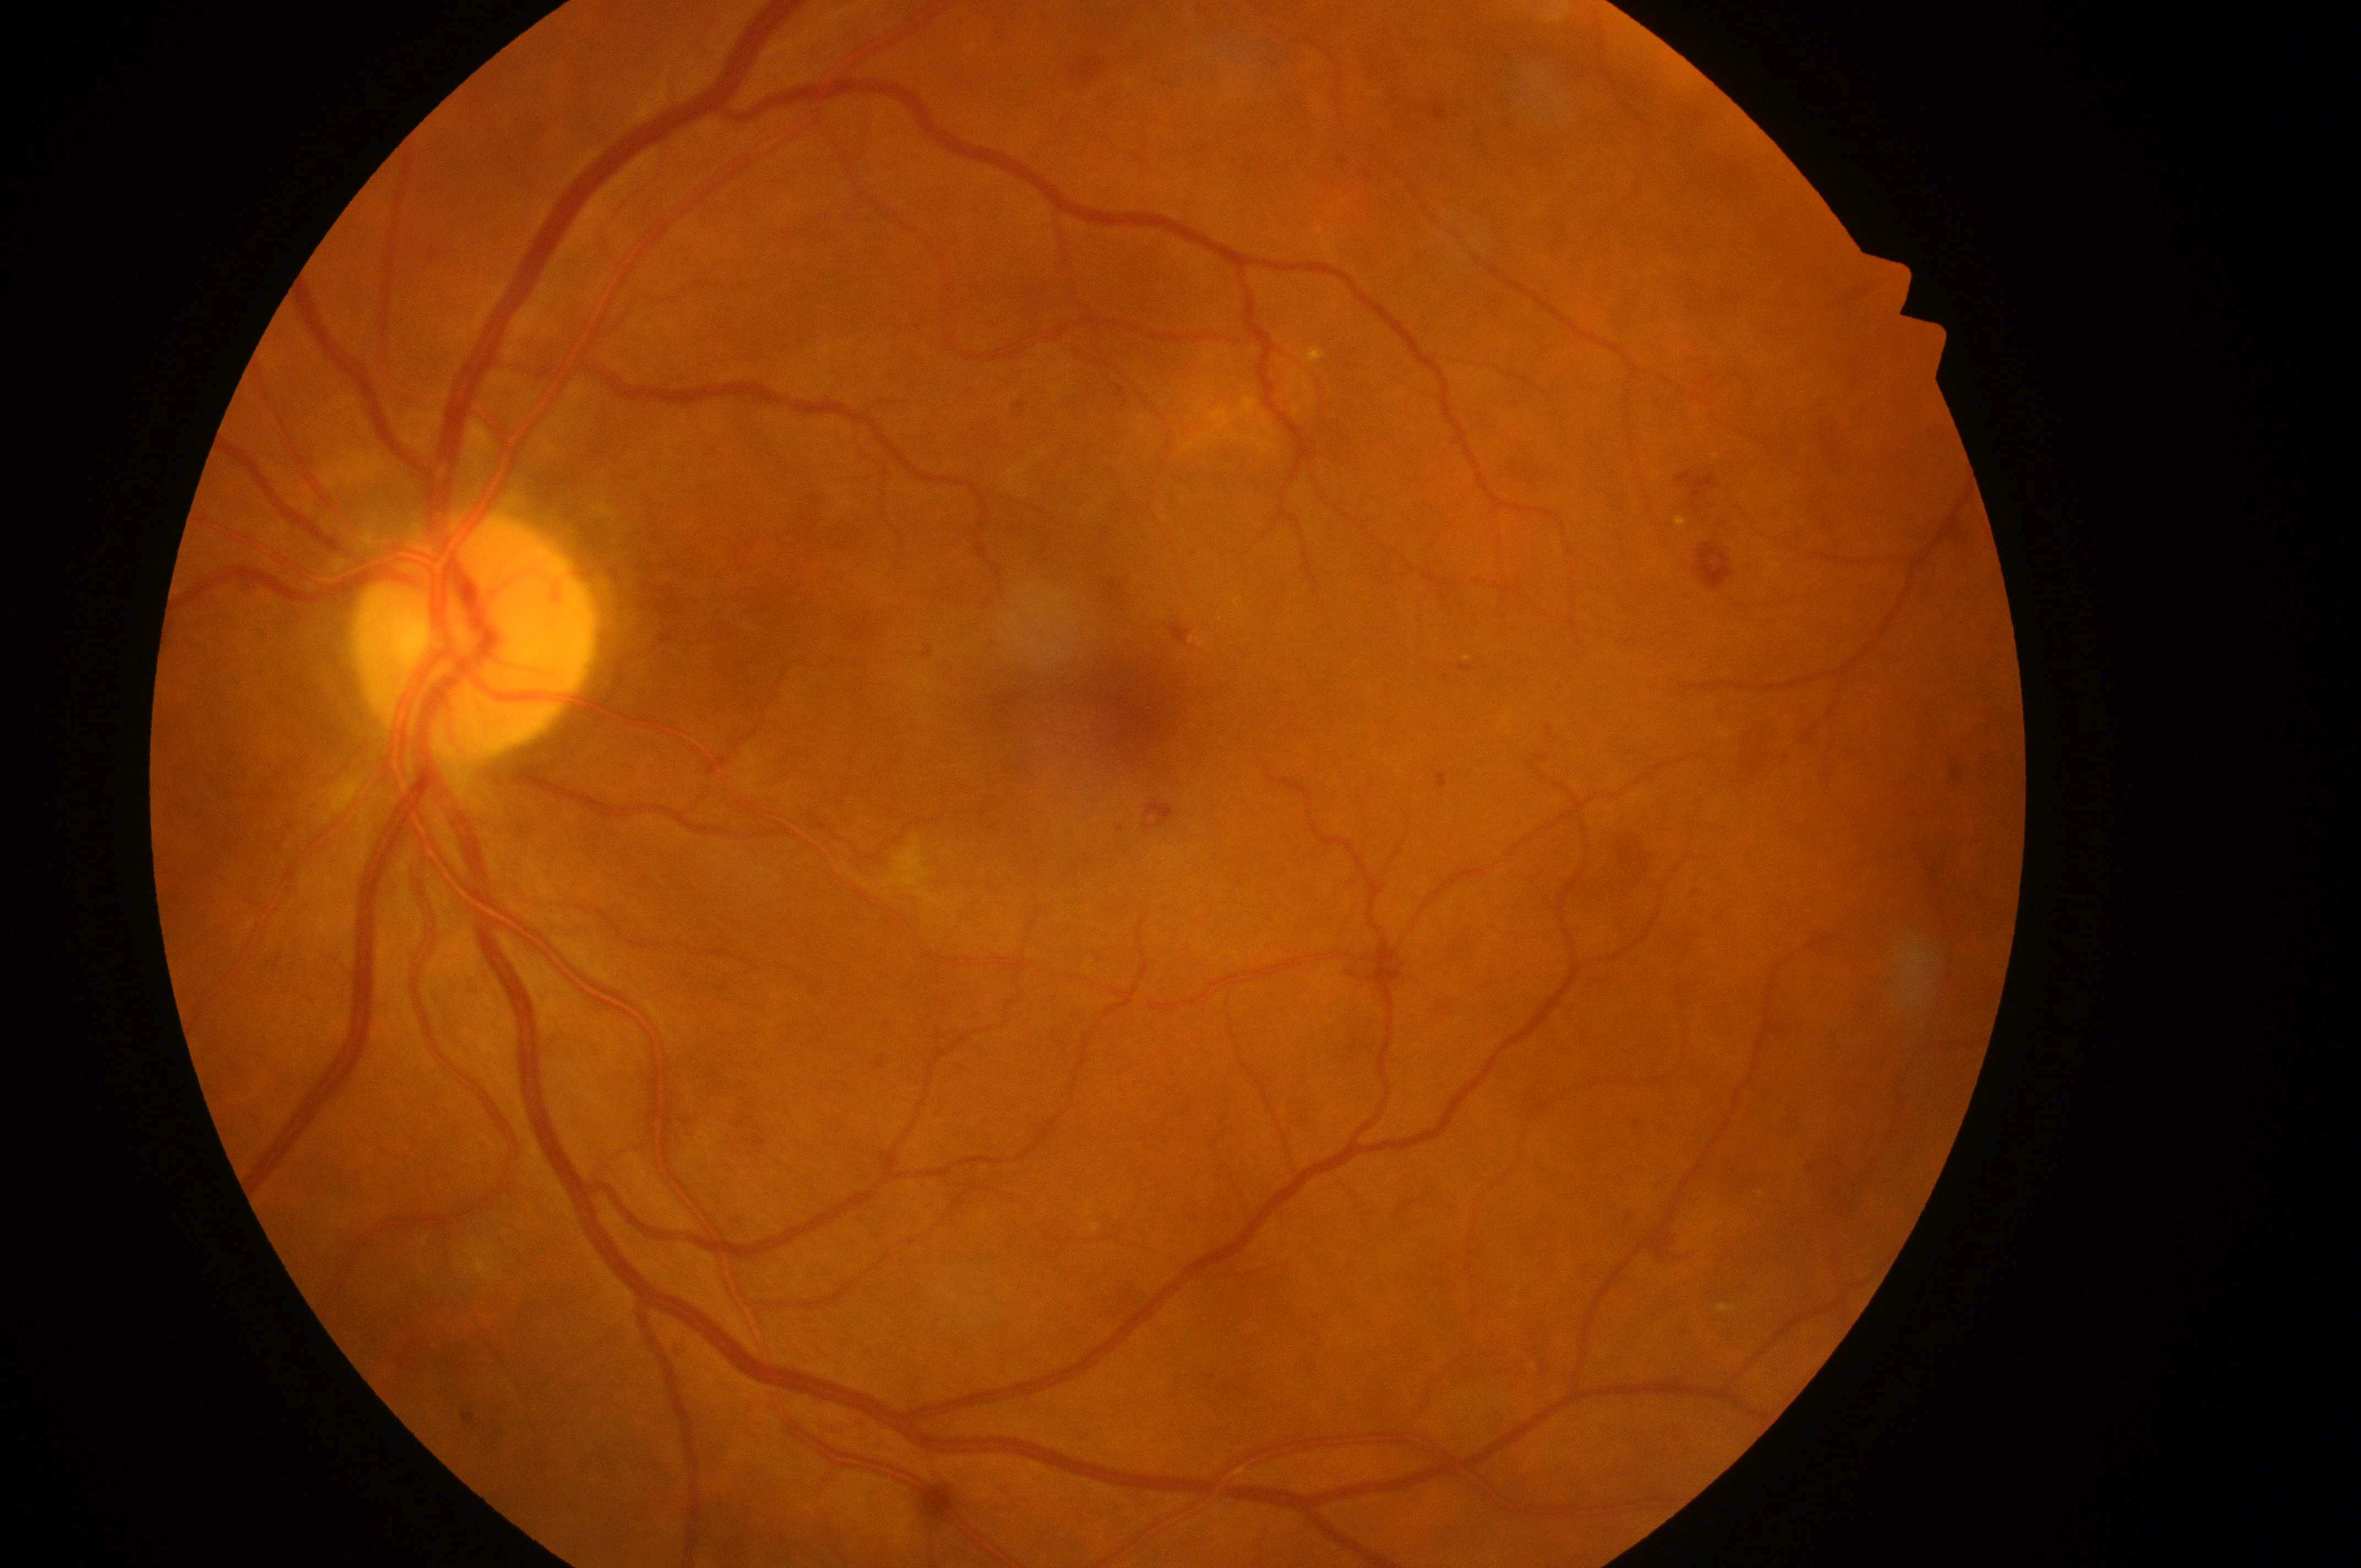

Annotations:
– macular edema risk: grade 2
– foveal center: (x=1134, y=713)
– optic nerve head: (x=470, y=645)
– retinopathy grade: 2
– laterality: left eye